45° field of view. Retinal fundus photograph — 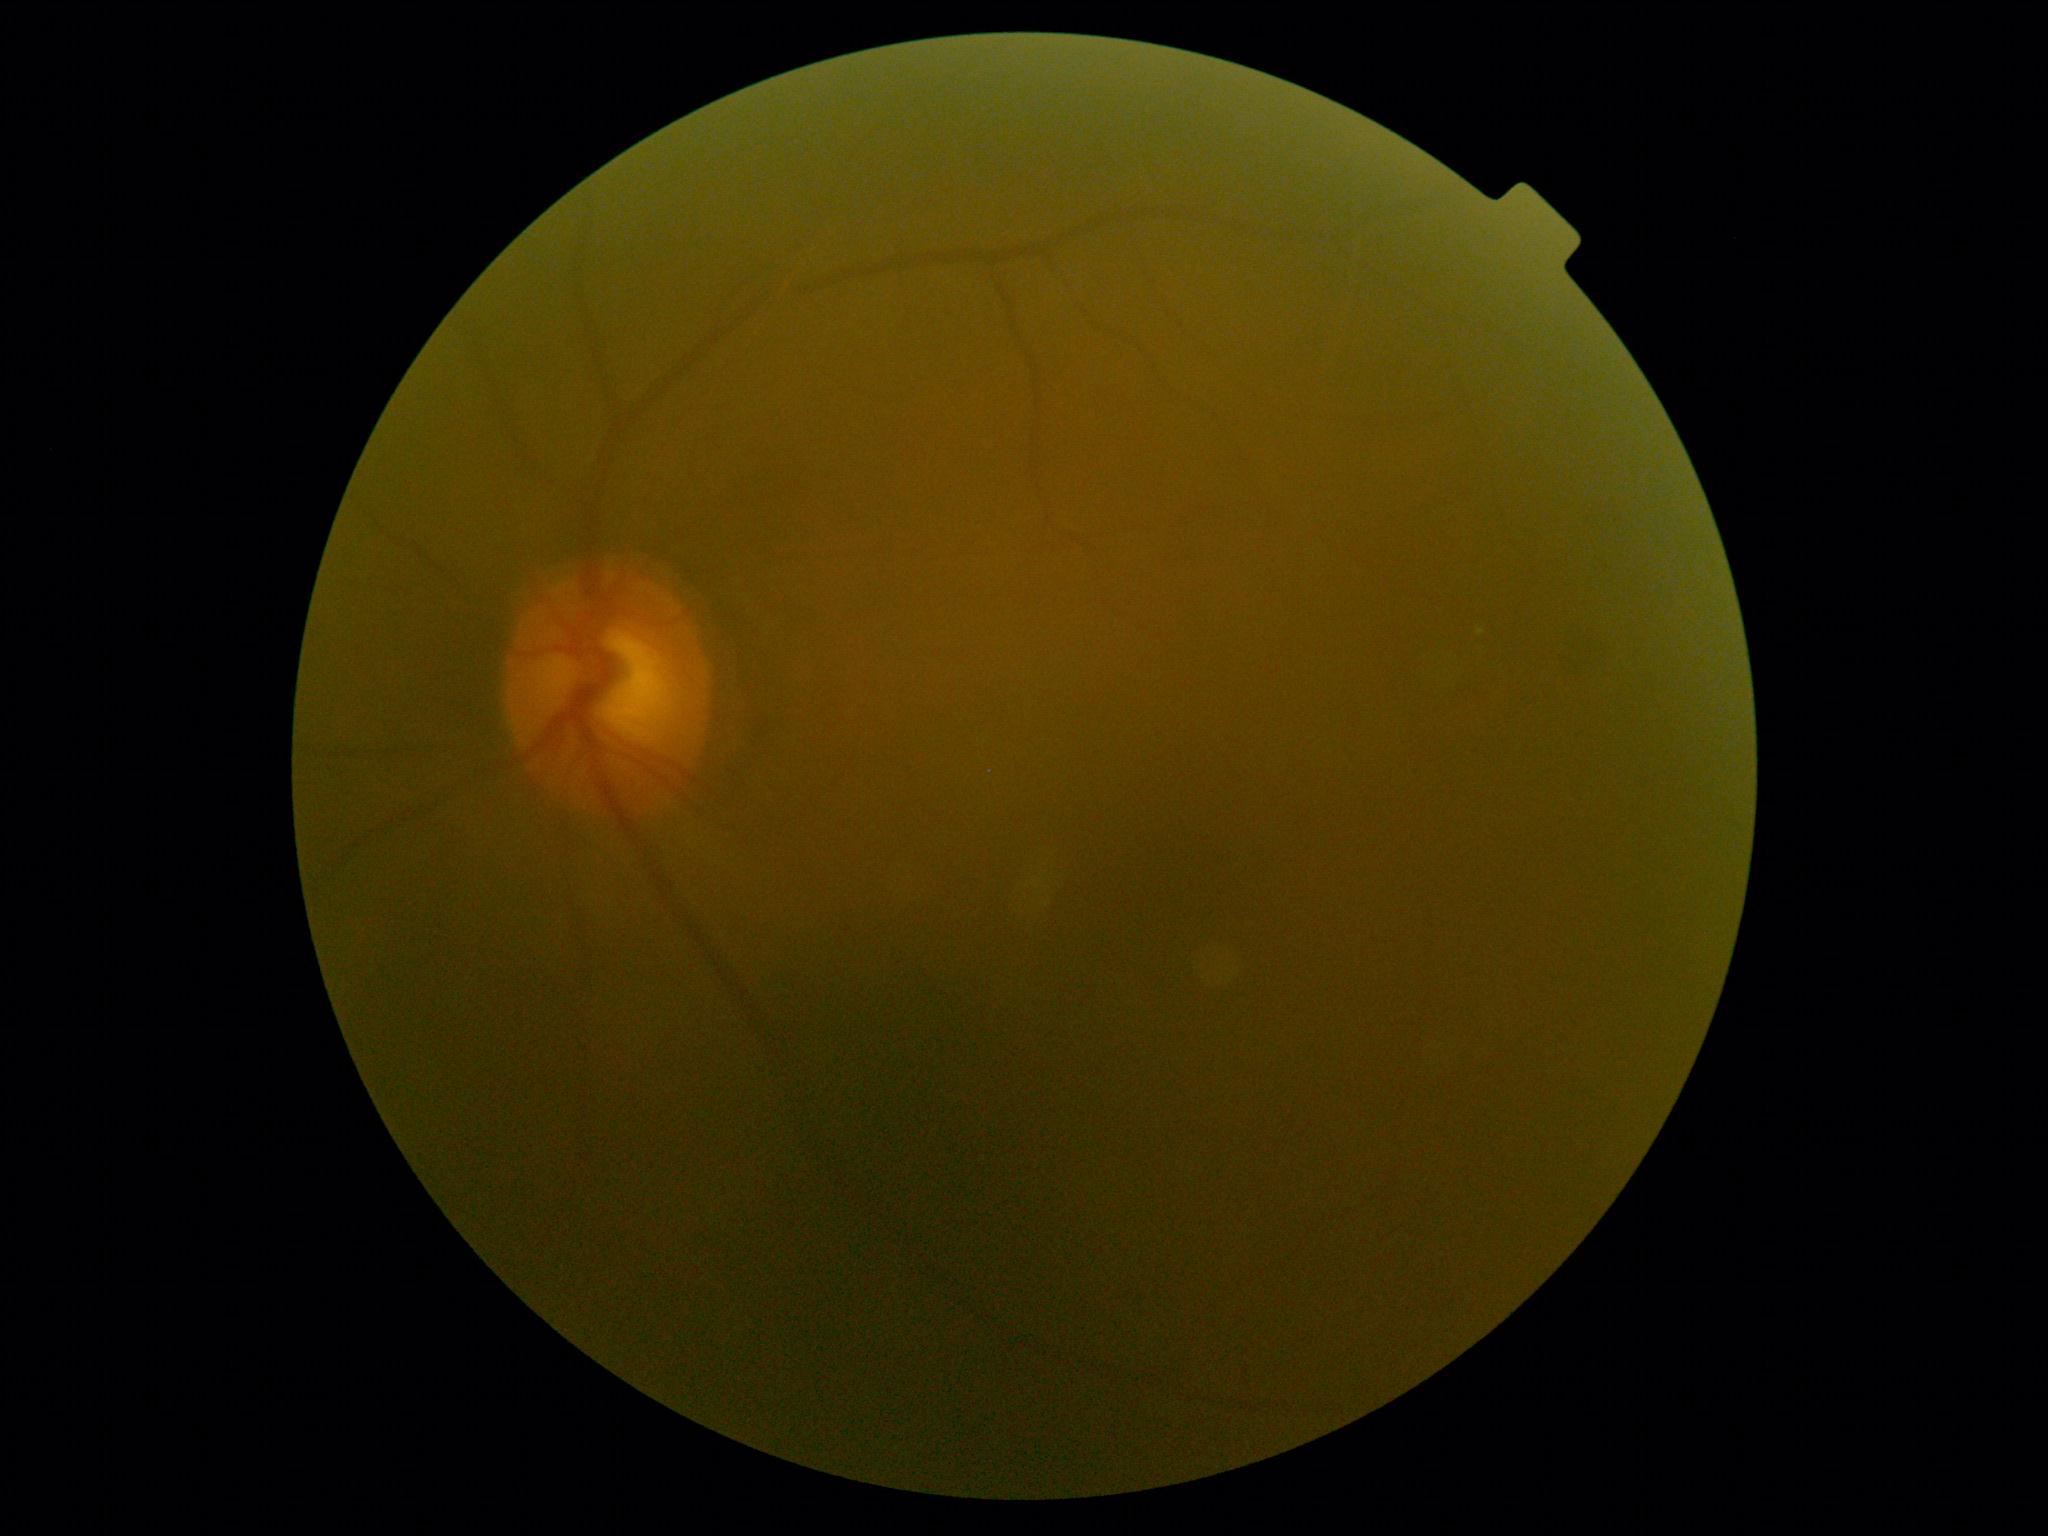

DR: moderate NPDR (grade 2).